Wide-field contact fundus photograph of an infant: 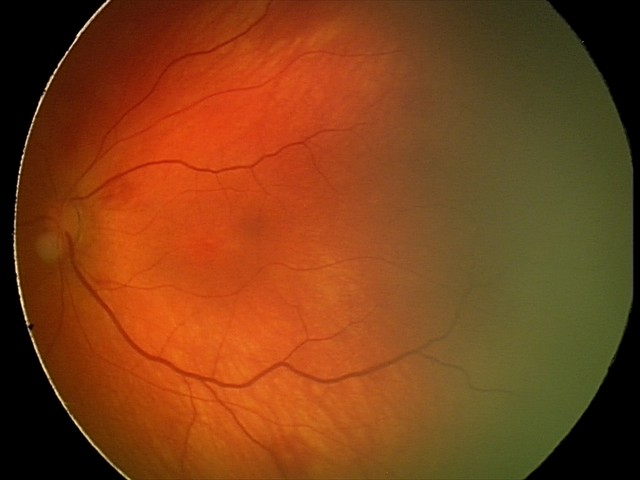

Screening: retinal hemorrhages.